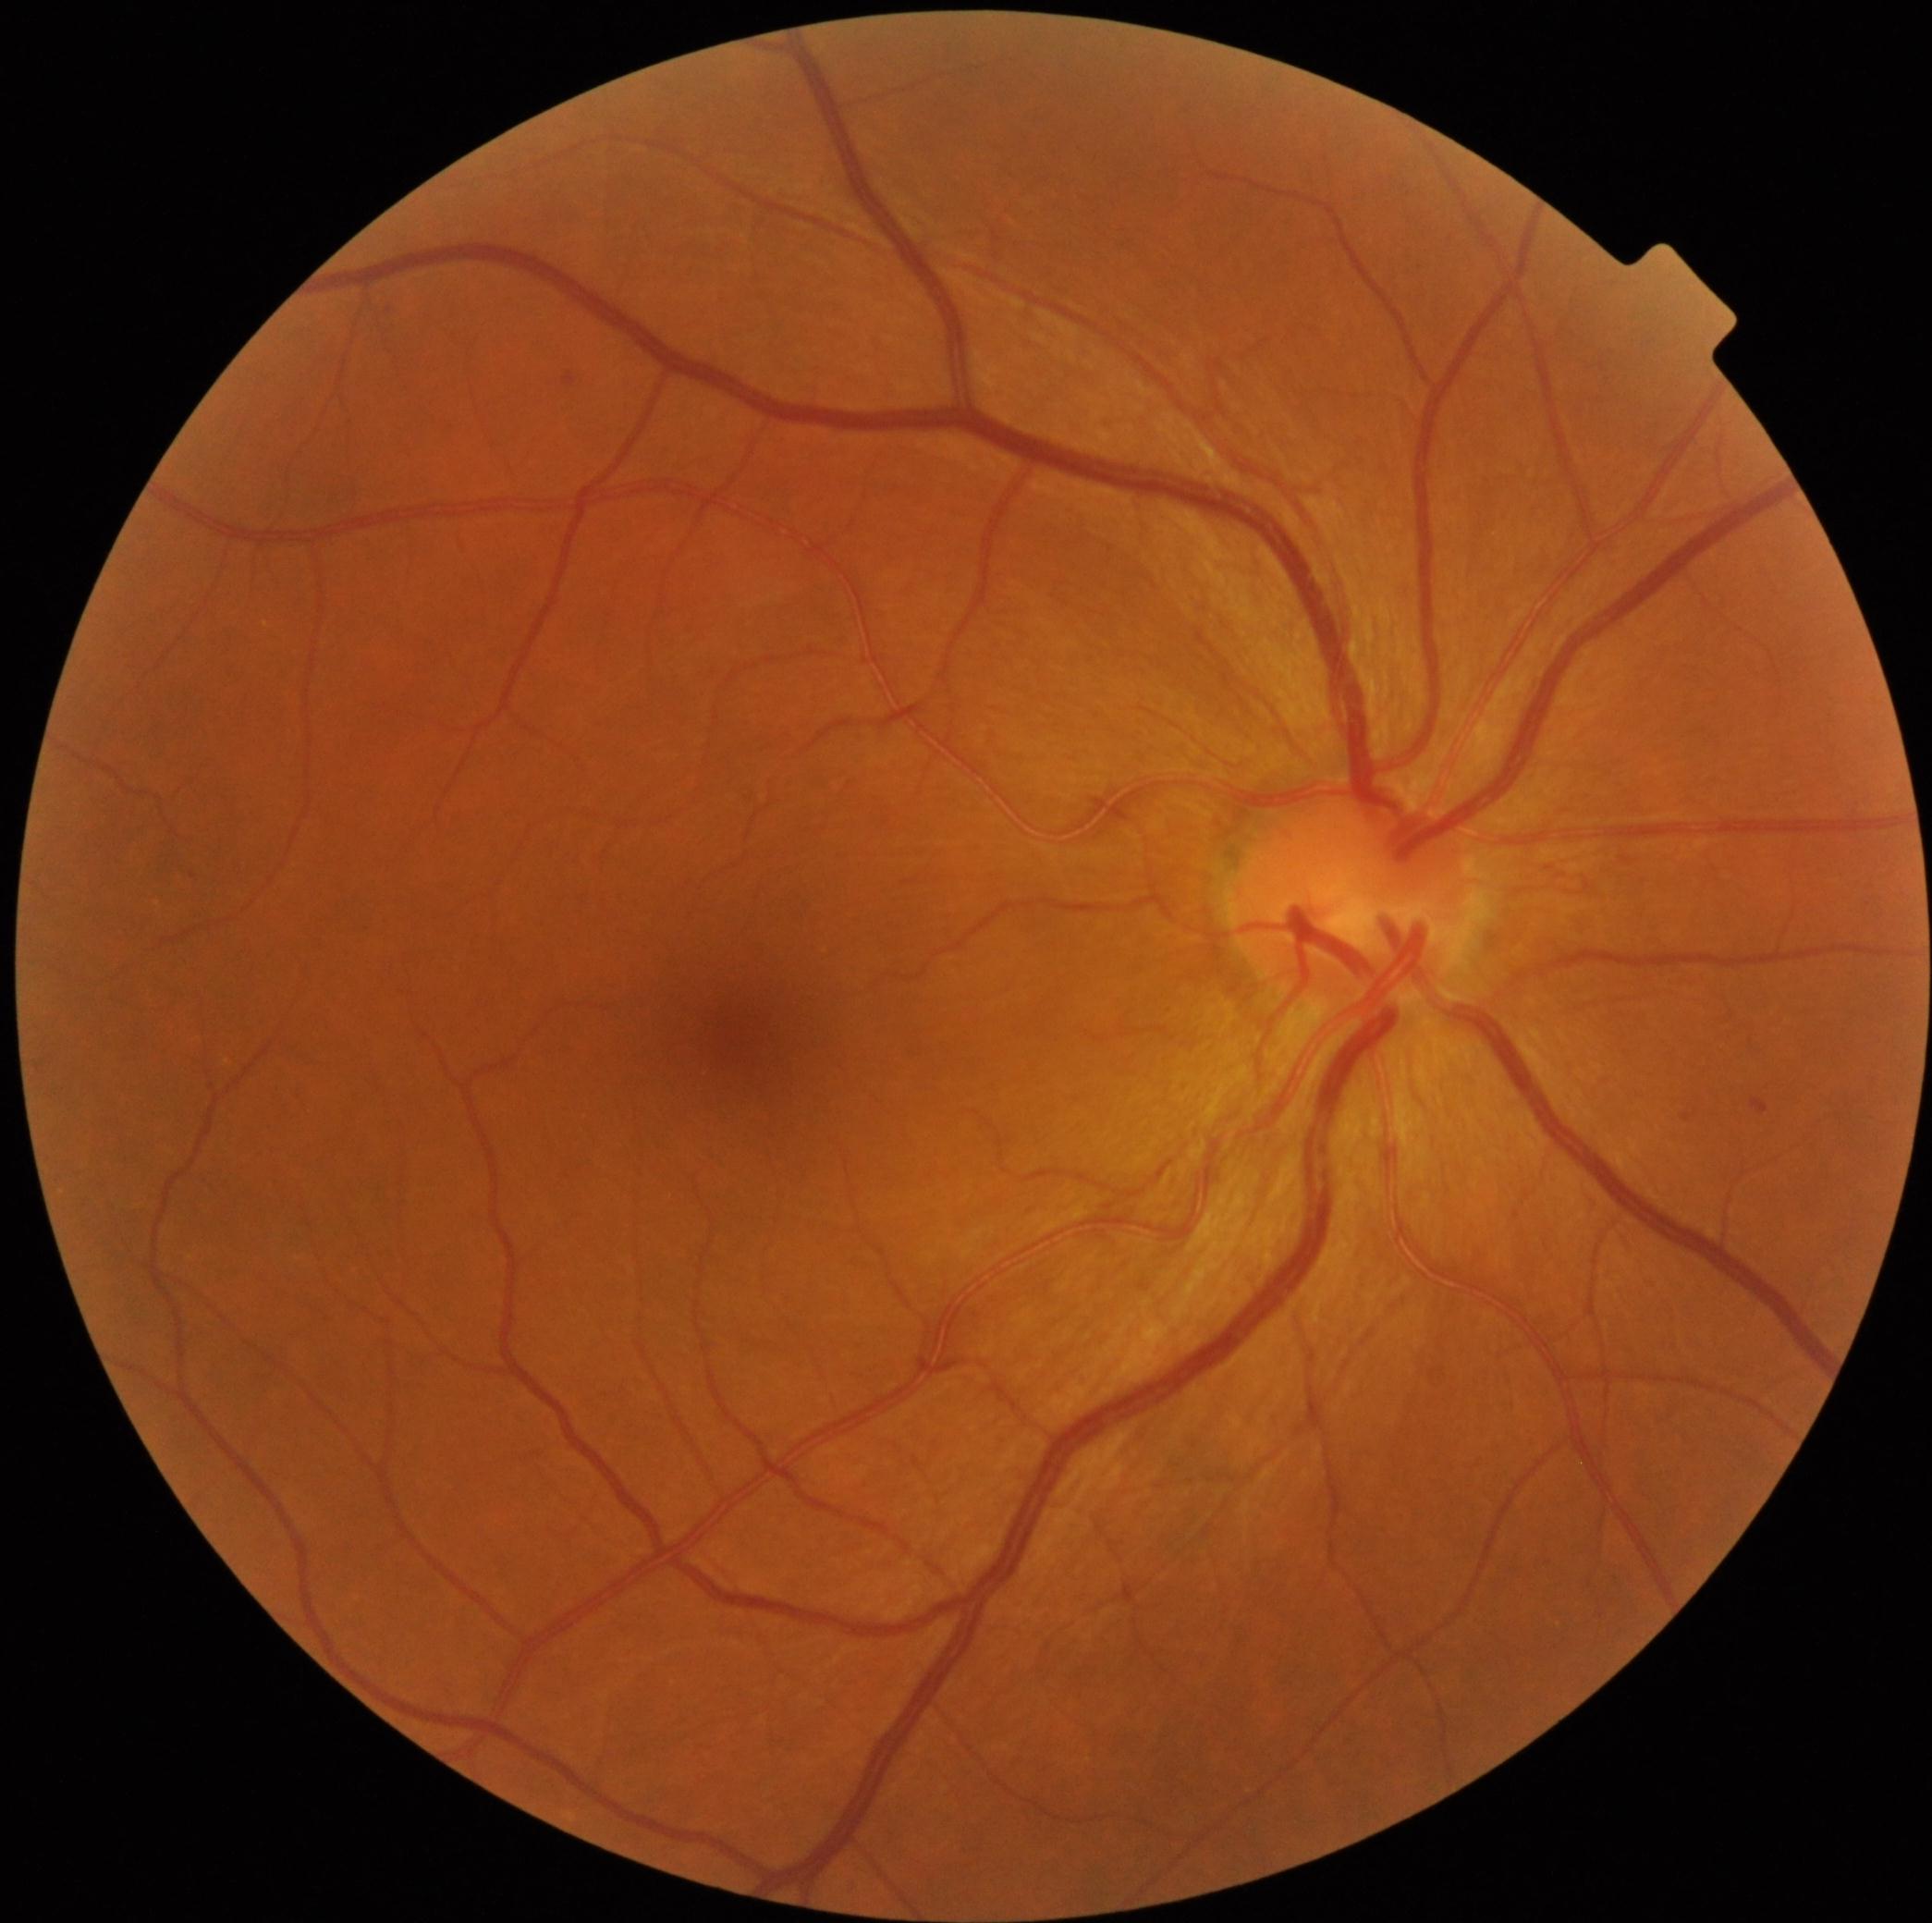

Diabetic retinopathy severity is mild non-proliferative diabetic retinopathy (grade 1).